Color fundus image
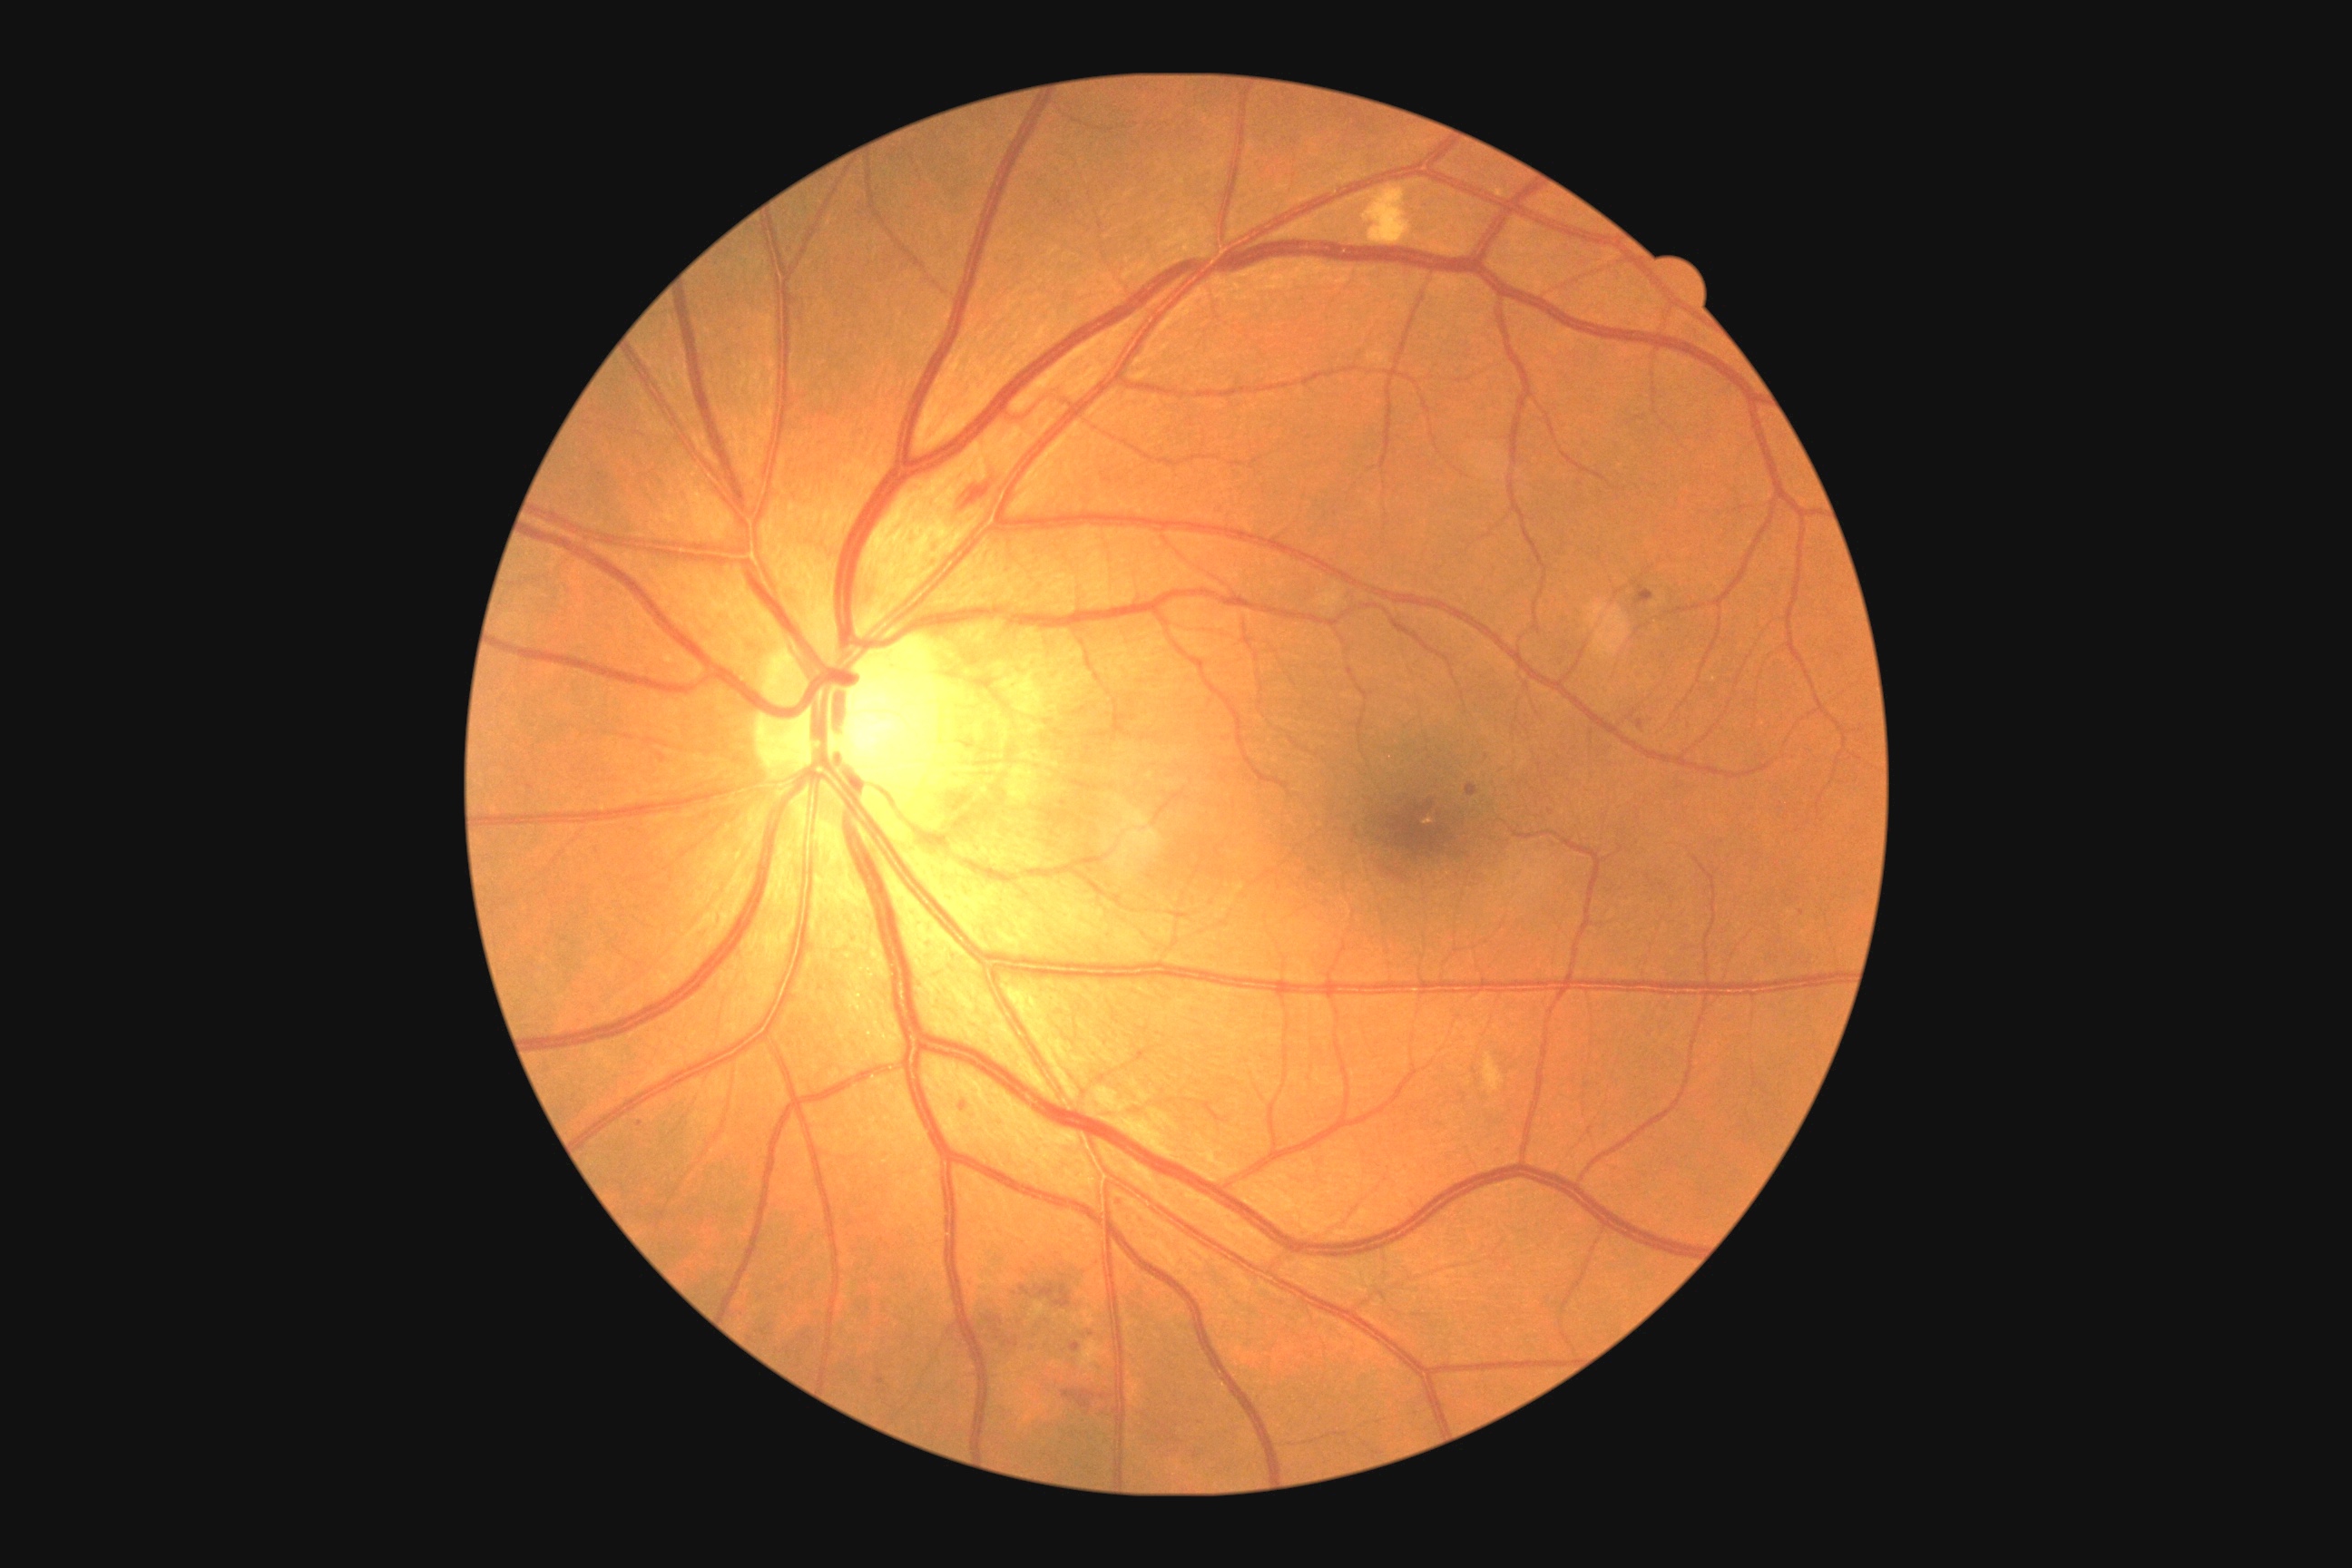 Retinopathy grade: 2. No hard exudates identified. Microaneurysms found at bbox=(876, 1378, 885, 1384); bbox=(1638, 720, 1643, 730); bbox=(1072, 1342, 1081, 1353); bbox=(1465, 783, 1478, 796); bbox=(1636, 587, 1654, 605); bbox=(658, 754, 667, 765). Microaneurysms (small, approximate centers) near (1802, 913); (963, 1107); (640, 1125); (1551, 812). Hemorrhages found at bbox=(1063, 1389, 1095, 1409); bbox=(961, 484, 992, 511); bbox=(1021, 1286, 1072, 1308); bbox=(990, 1318, 1017, 1351). Soft exudates found at bbox=(1357, 186, 1413, 246); bbox=(1081, 1340, 1102, 1373); bbox=(1484, 1054, 1504, 1092).